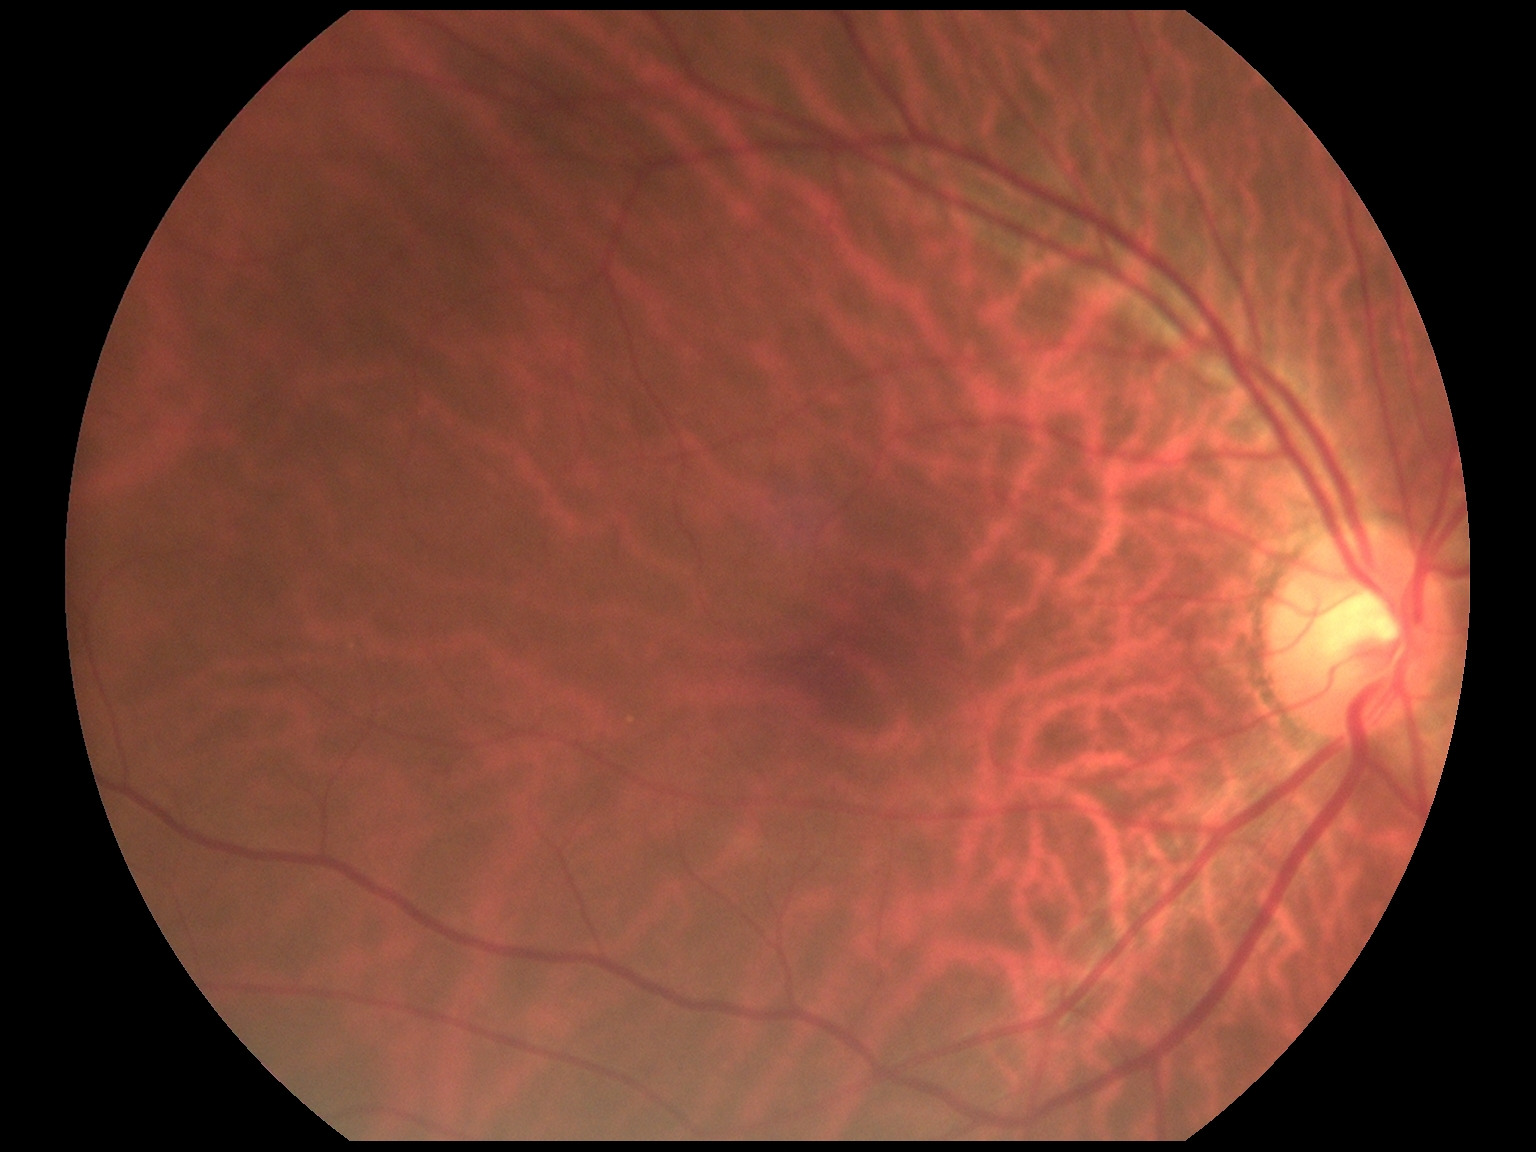
DR impression=no apparent DR; retinopathy grade=0 (no apparent retinopathy).